1536 by 1152 pixels
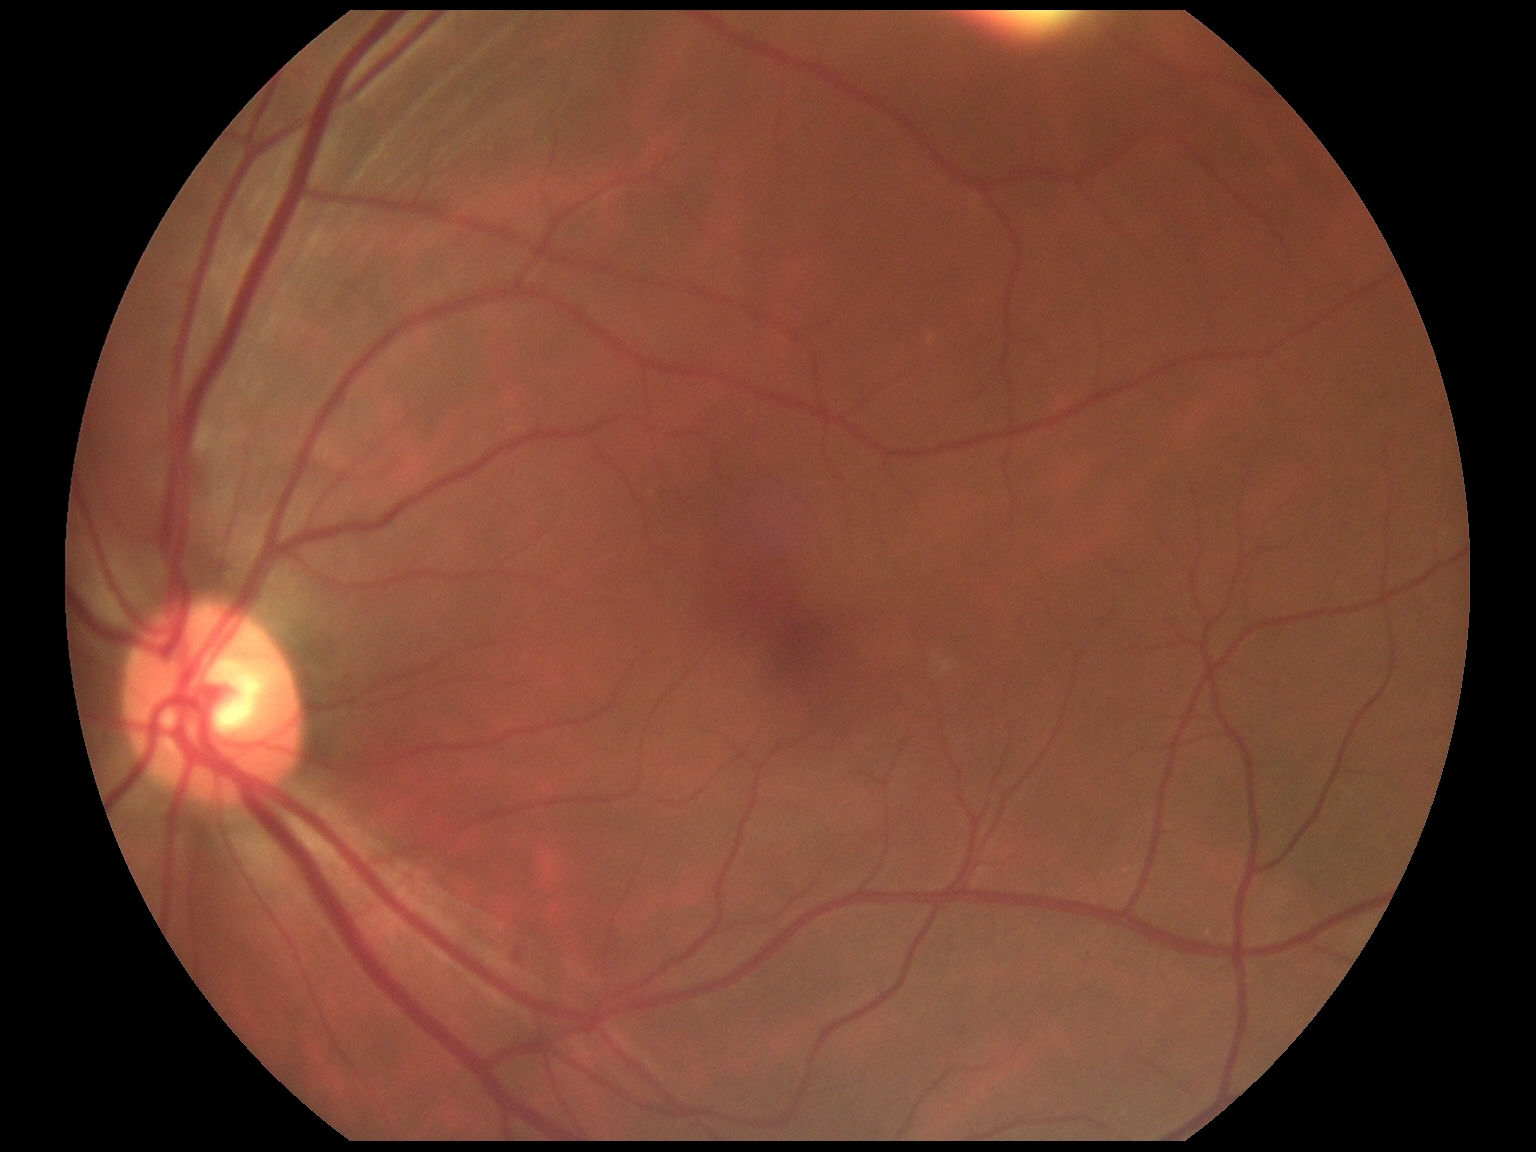 Annotations:
* DR impression — negative for DR
* retinopathy — no apparent retinopathy (grade 0) — no visible signs of diabetic retinopathy